Graded on the modified Davis scale.
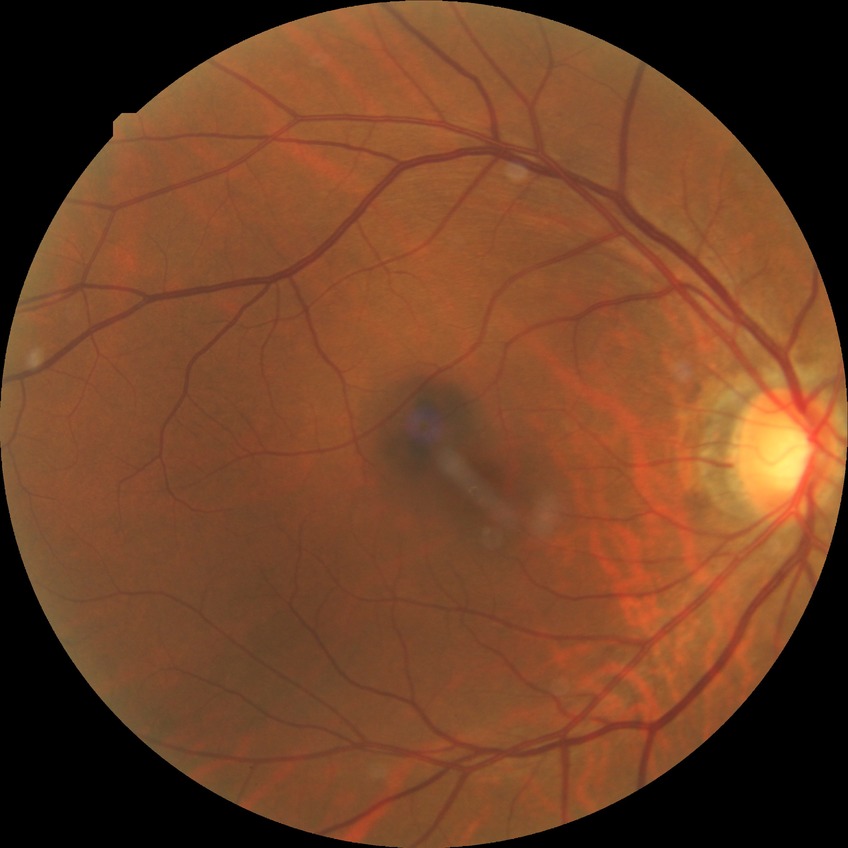
Modified Davis grade is SDR.